Modified Davis grading:
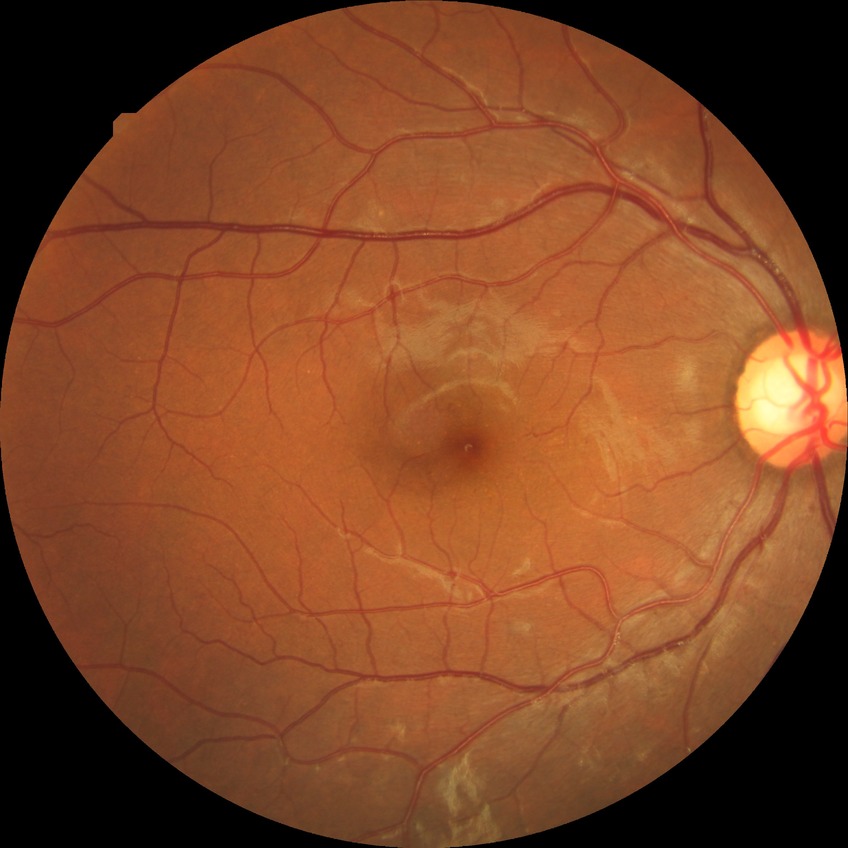 davis_grade: SDR